Color fundus photograph · 848x848 · NIDEK AFC-230 · DR severity per modified Davis staging:
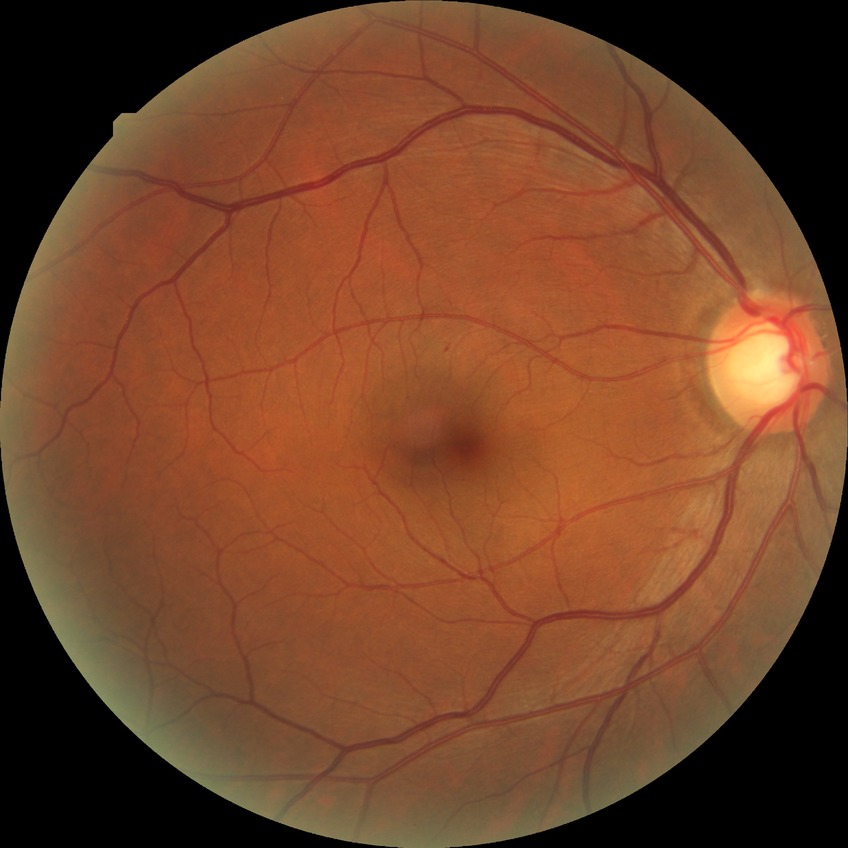

Diabetic retinopathy (DR) is simple diabetic retinopathy (SDR).